Fundus photo. 2212 by 1659 pixels.
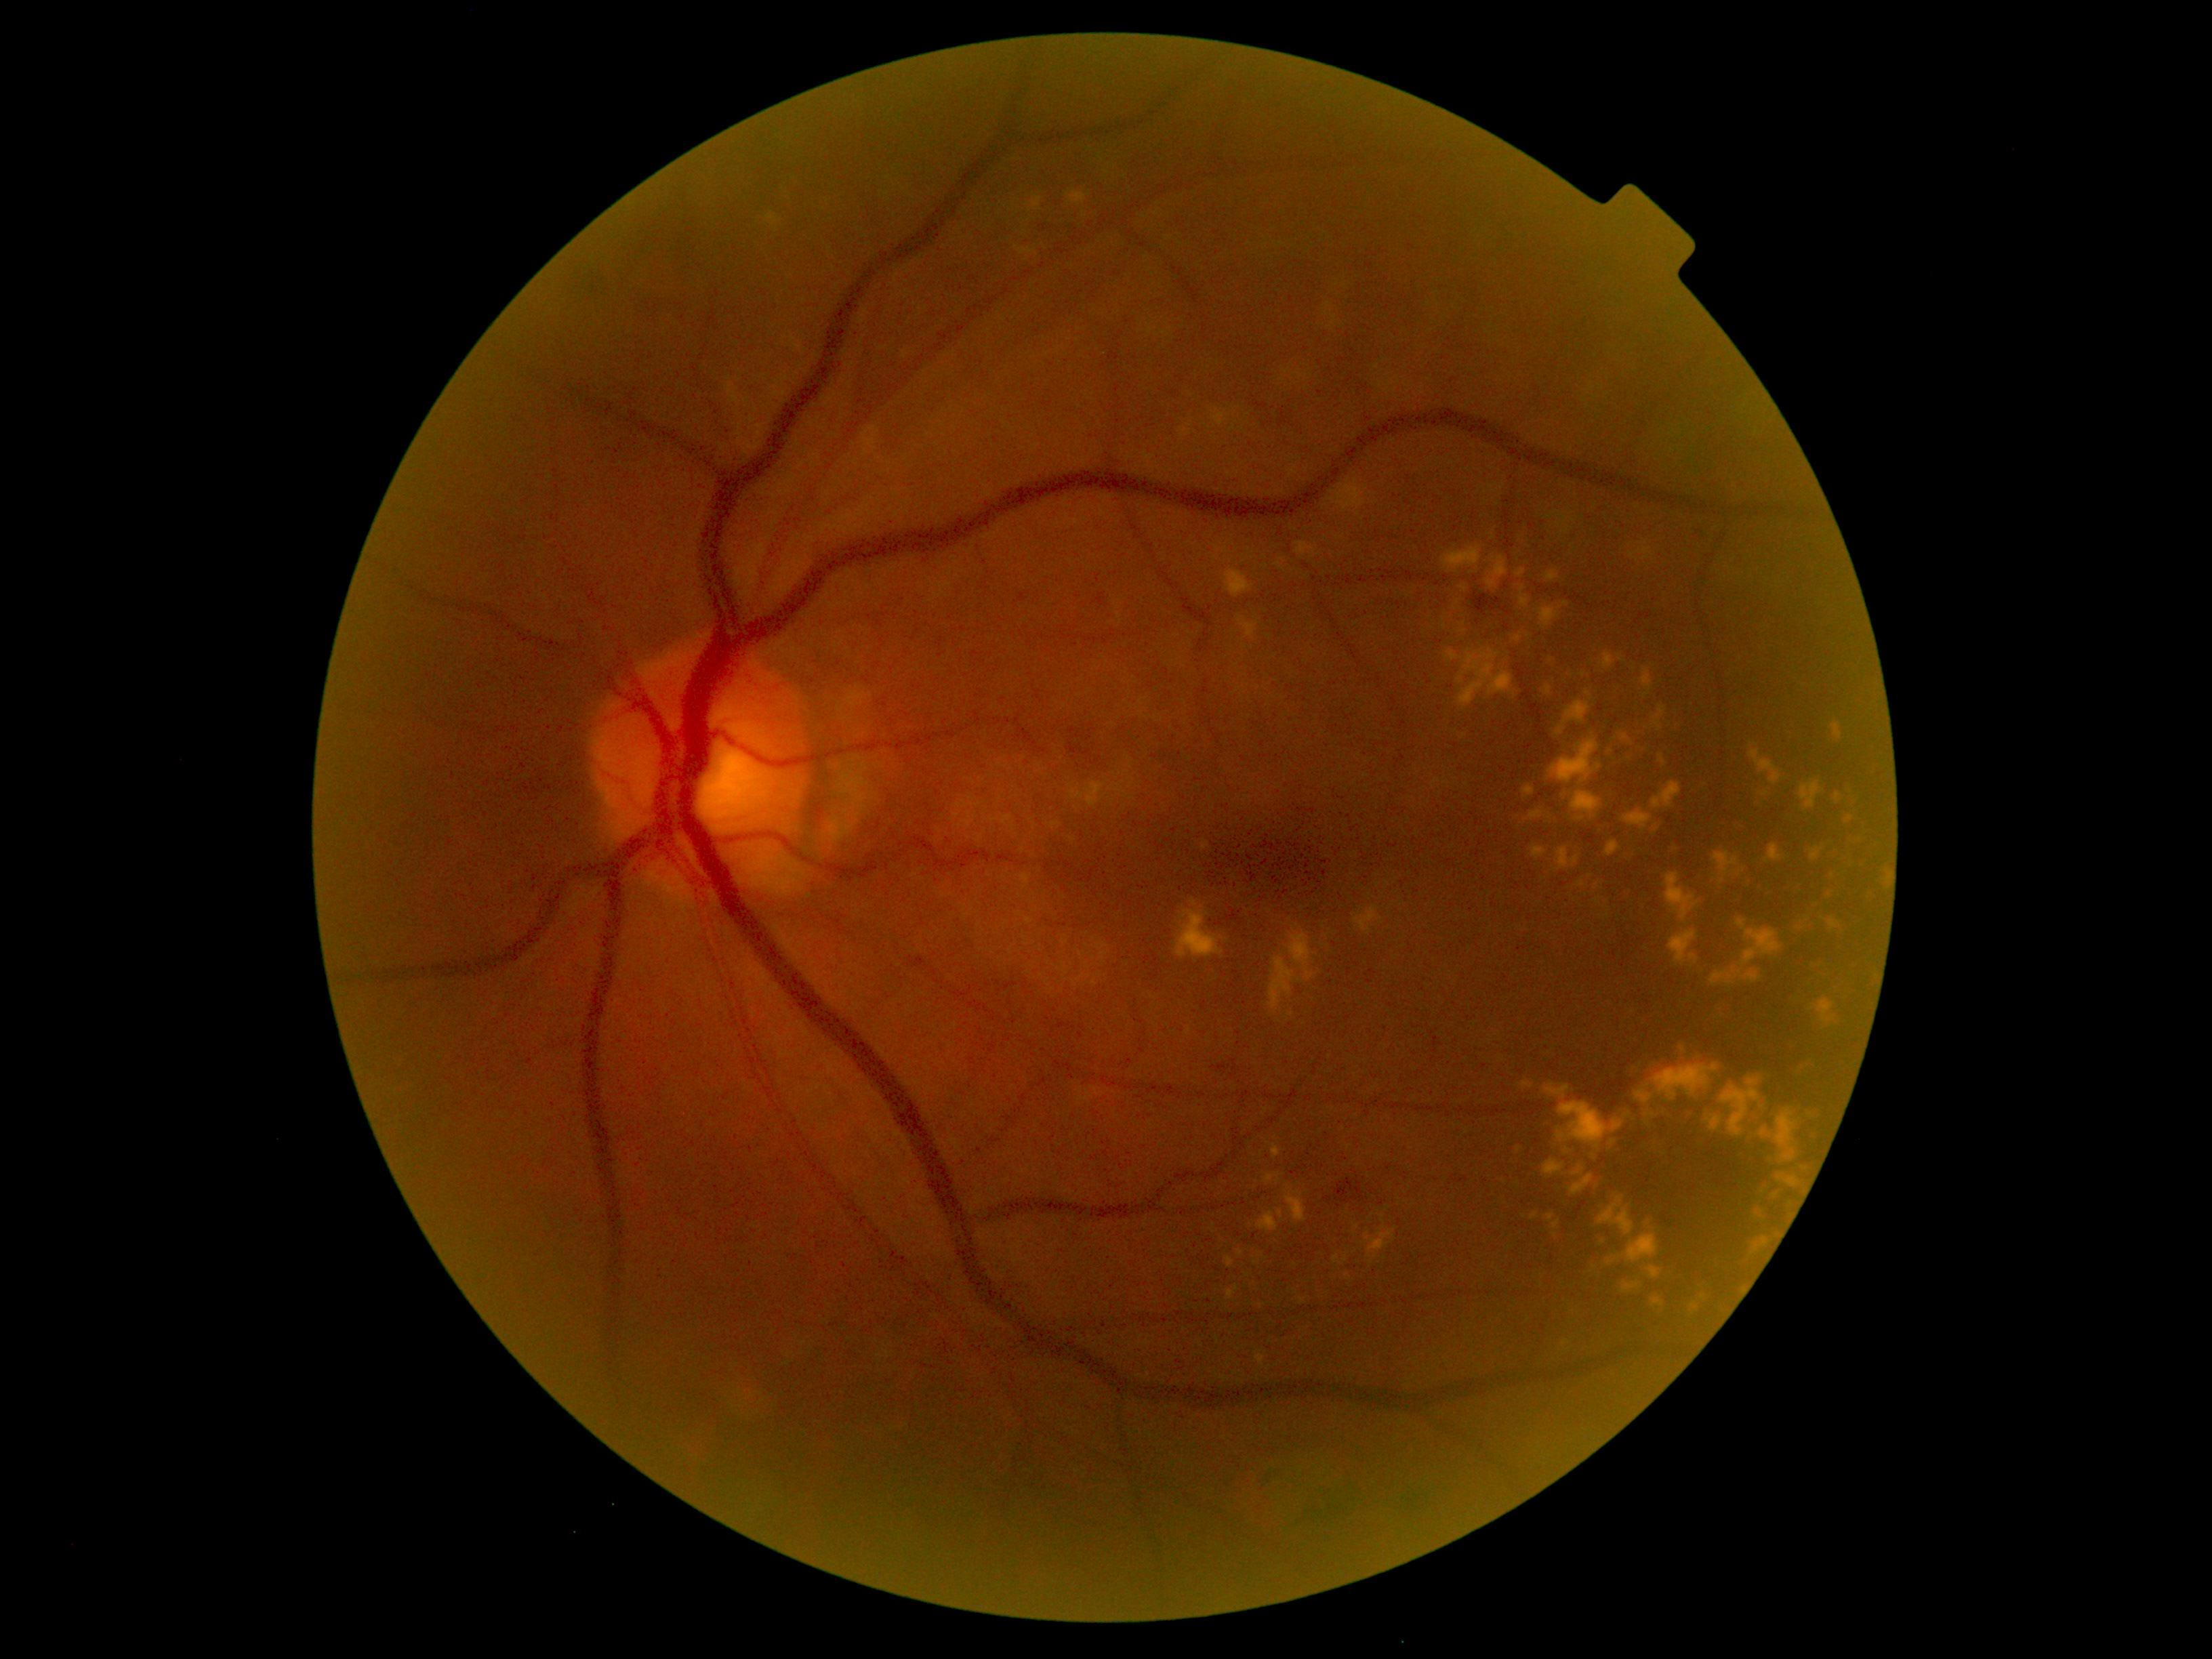
Diabetic retinopathy severity is moderate non-proliferative diabetic retinopathy (grade 2); non-proliferative diabetic retinopathy
Selected lesions:
hard exudates (more not shown): 1811:848:1824:861 | 1607:841:1620:857 | 1578:878:1637:921 | 1654:707:1665:730 | 1329:480:1366:513 | 1516:569:1525:578 | 1570:790:1603:821 | 1652:783:1683:808 | 1256:1355:1265:1367 | 1802:1107:1825:1127 | 1446:556:1558:710 | 1264:1173:1282:1184 | 1296:541:1317:559 | 1238:1249:1245:1257 | 1801:781:1824:808
Smaller hard exudates around (x=1556, y=1236) | (x=1535, y=1215) | (x=1722, y=882) | (x=1266, y=1110) | (x=1656, y=829)